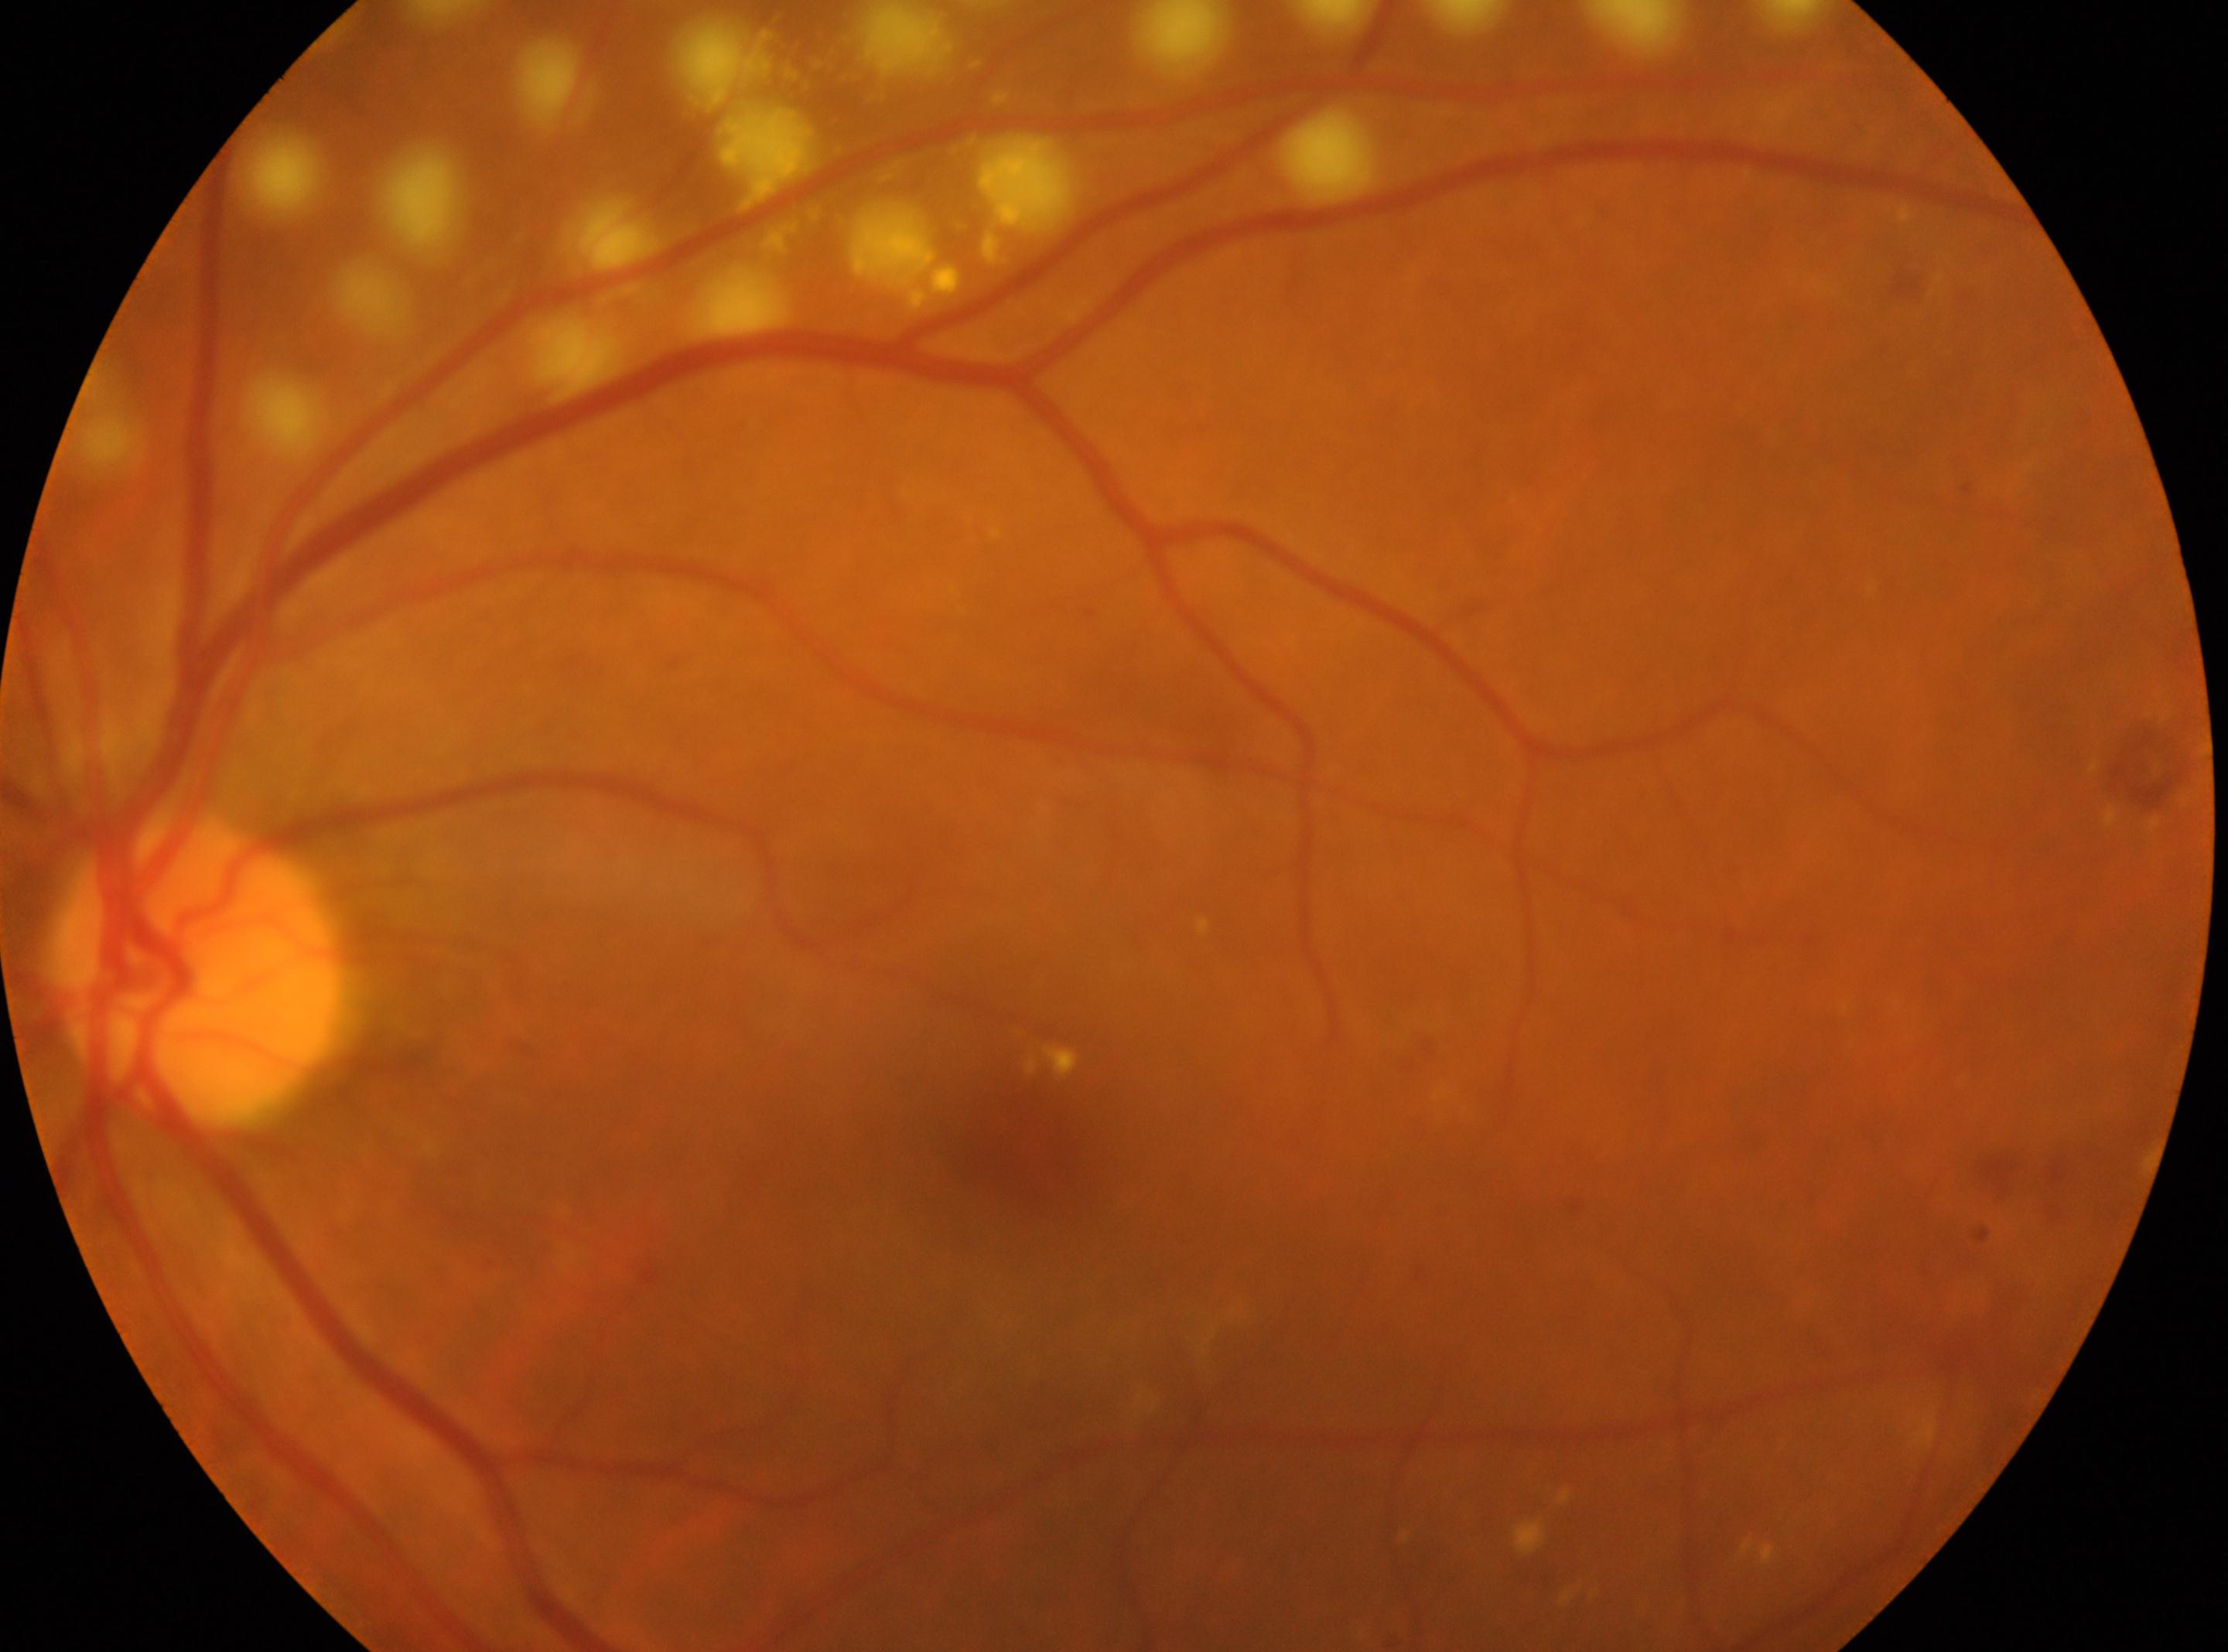
The fovea centralis is at (1020,1131). Disc center: (194,973). Imaged eye: left eye. Diabetic retinopathy (DR): post-laser DR, underlying severity grade 2 (moderate NPDR).